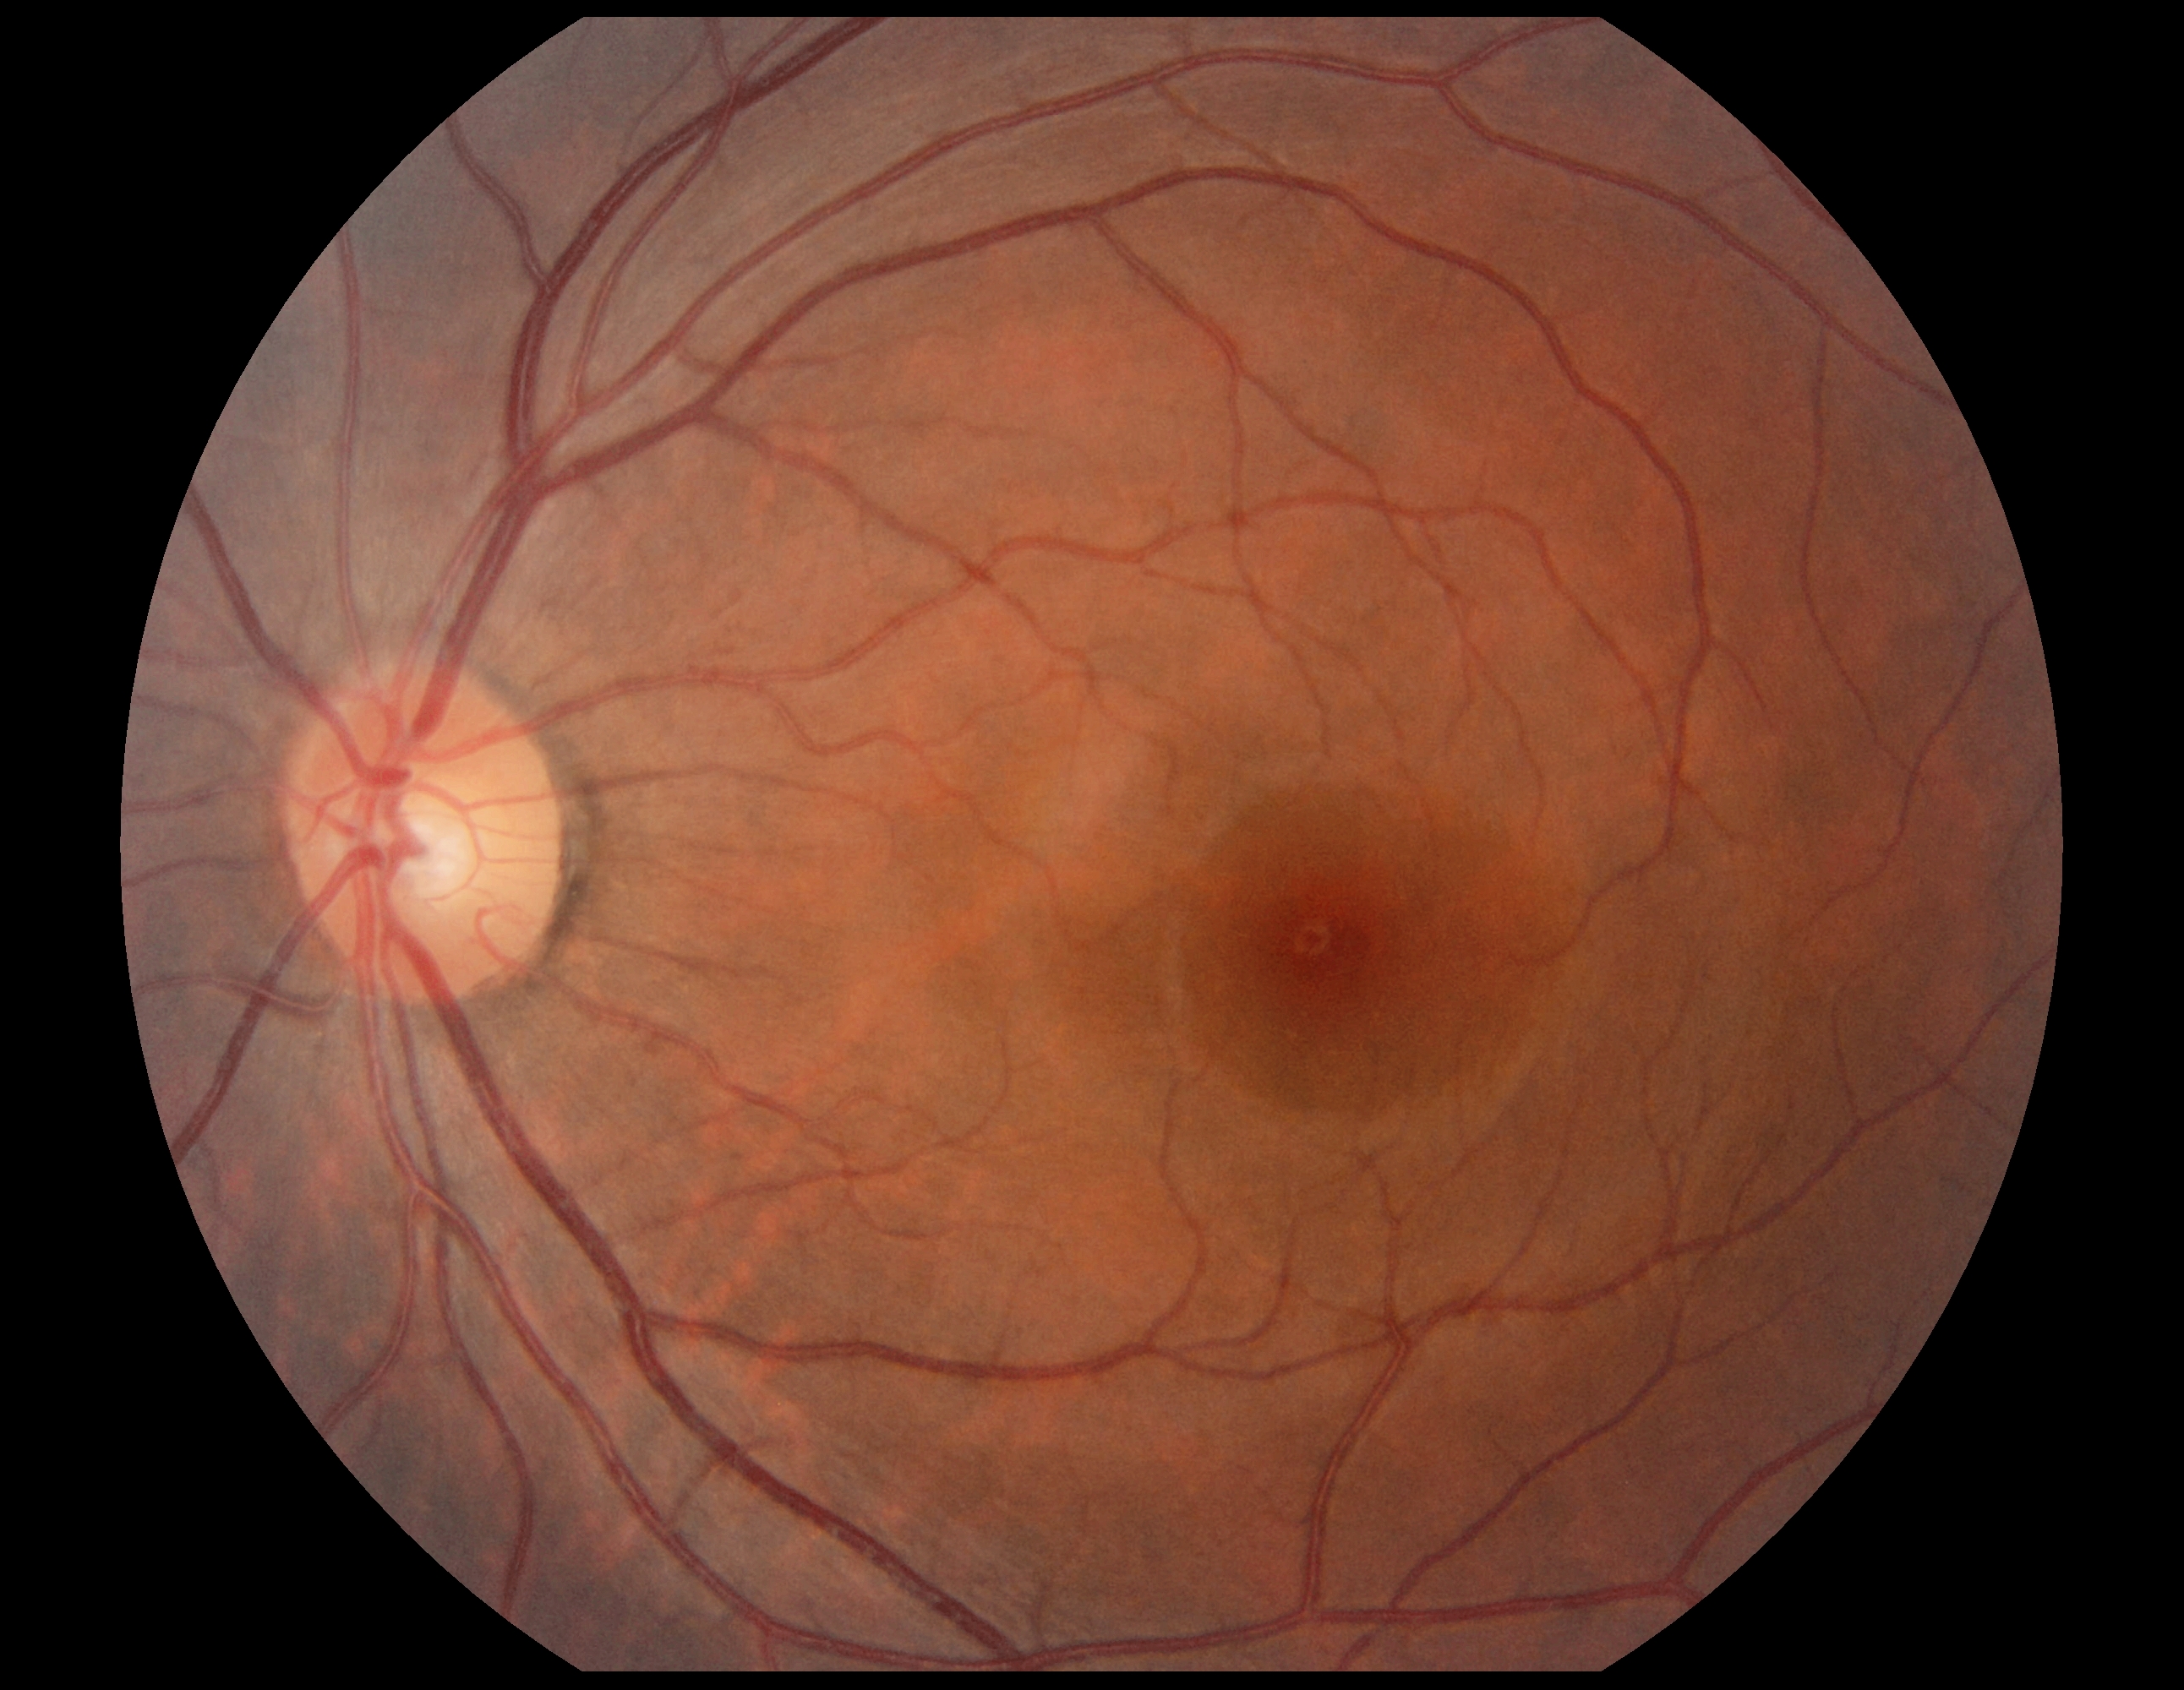
Diabetic retinopathy severity is no apparent diabetic retinopathy (grade 0).